Nonmydriatic fundus photograph; 45 degree fundus photograph; fundus photo
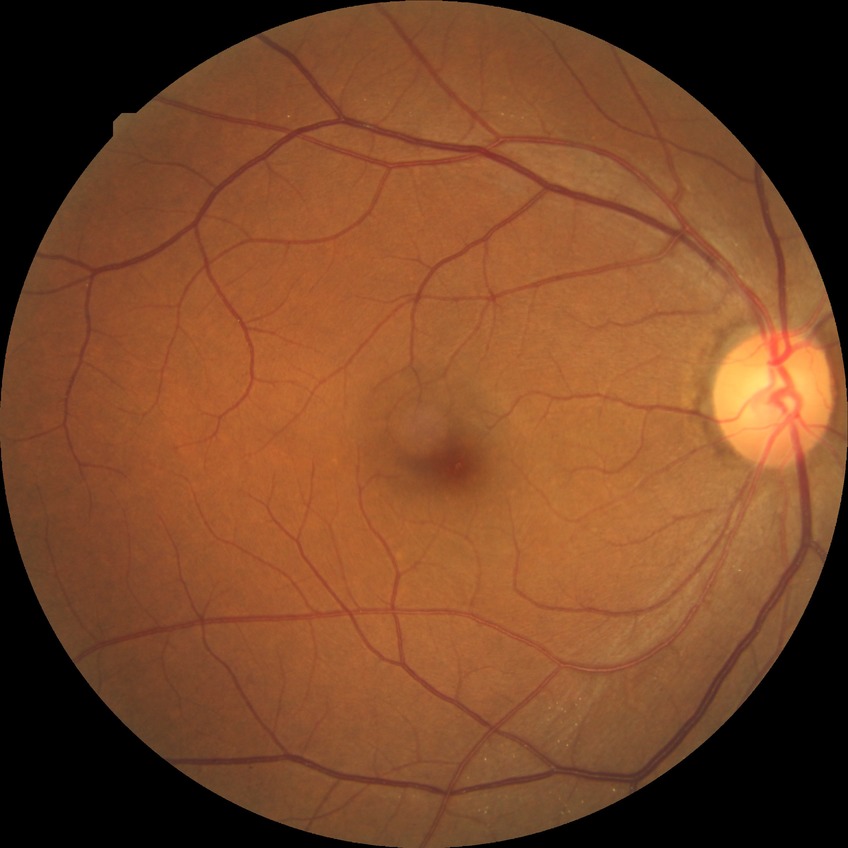 diabetic retinopathy (DR) = SDR (simple diabetic retinopathy)